45° field of view
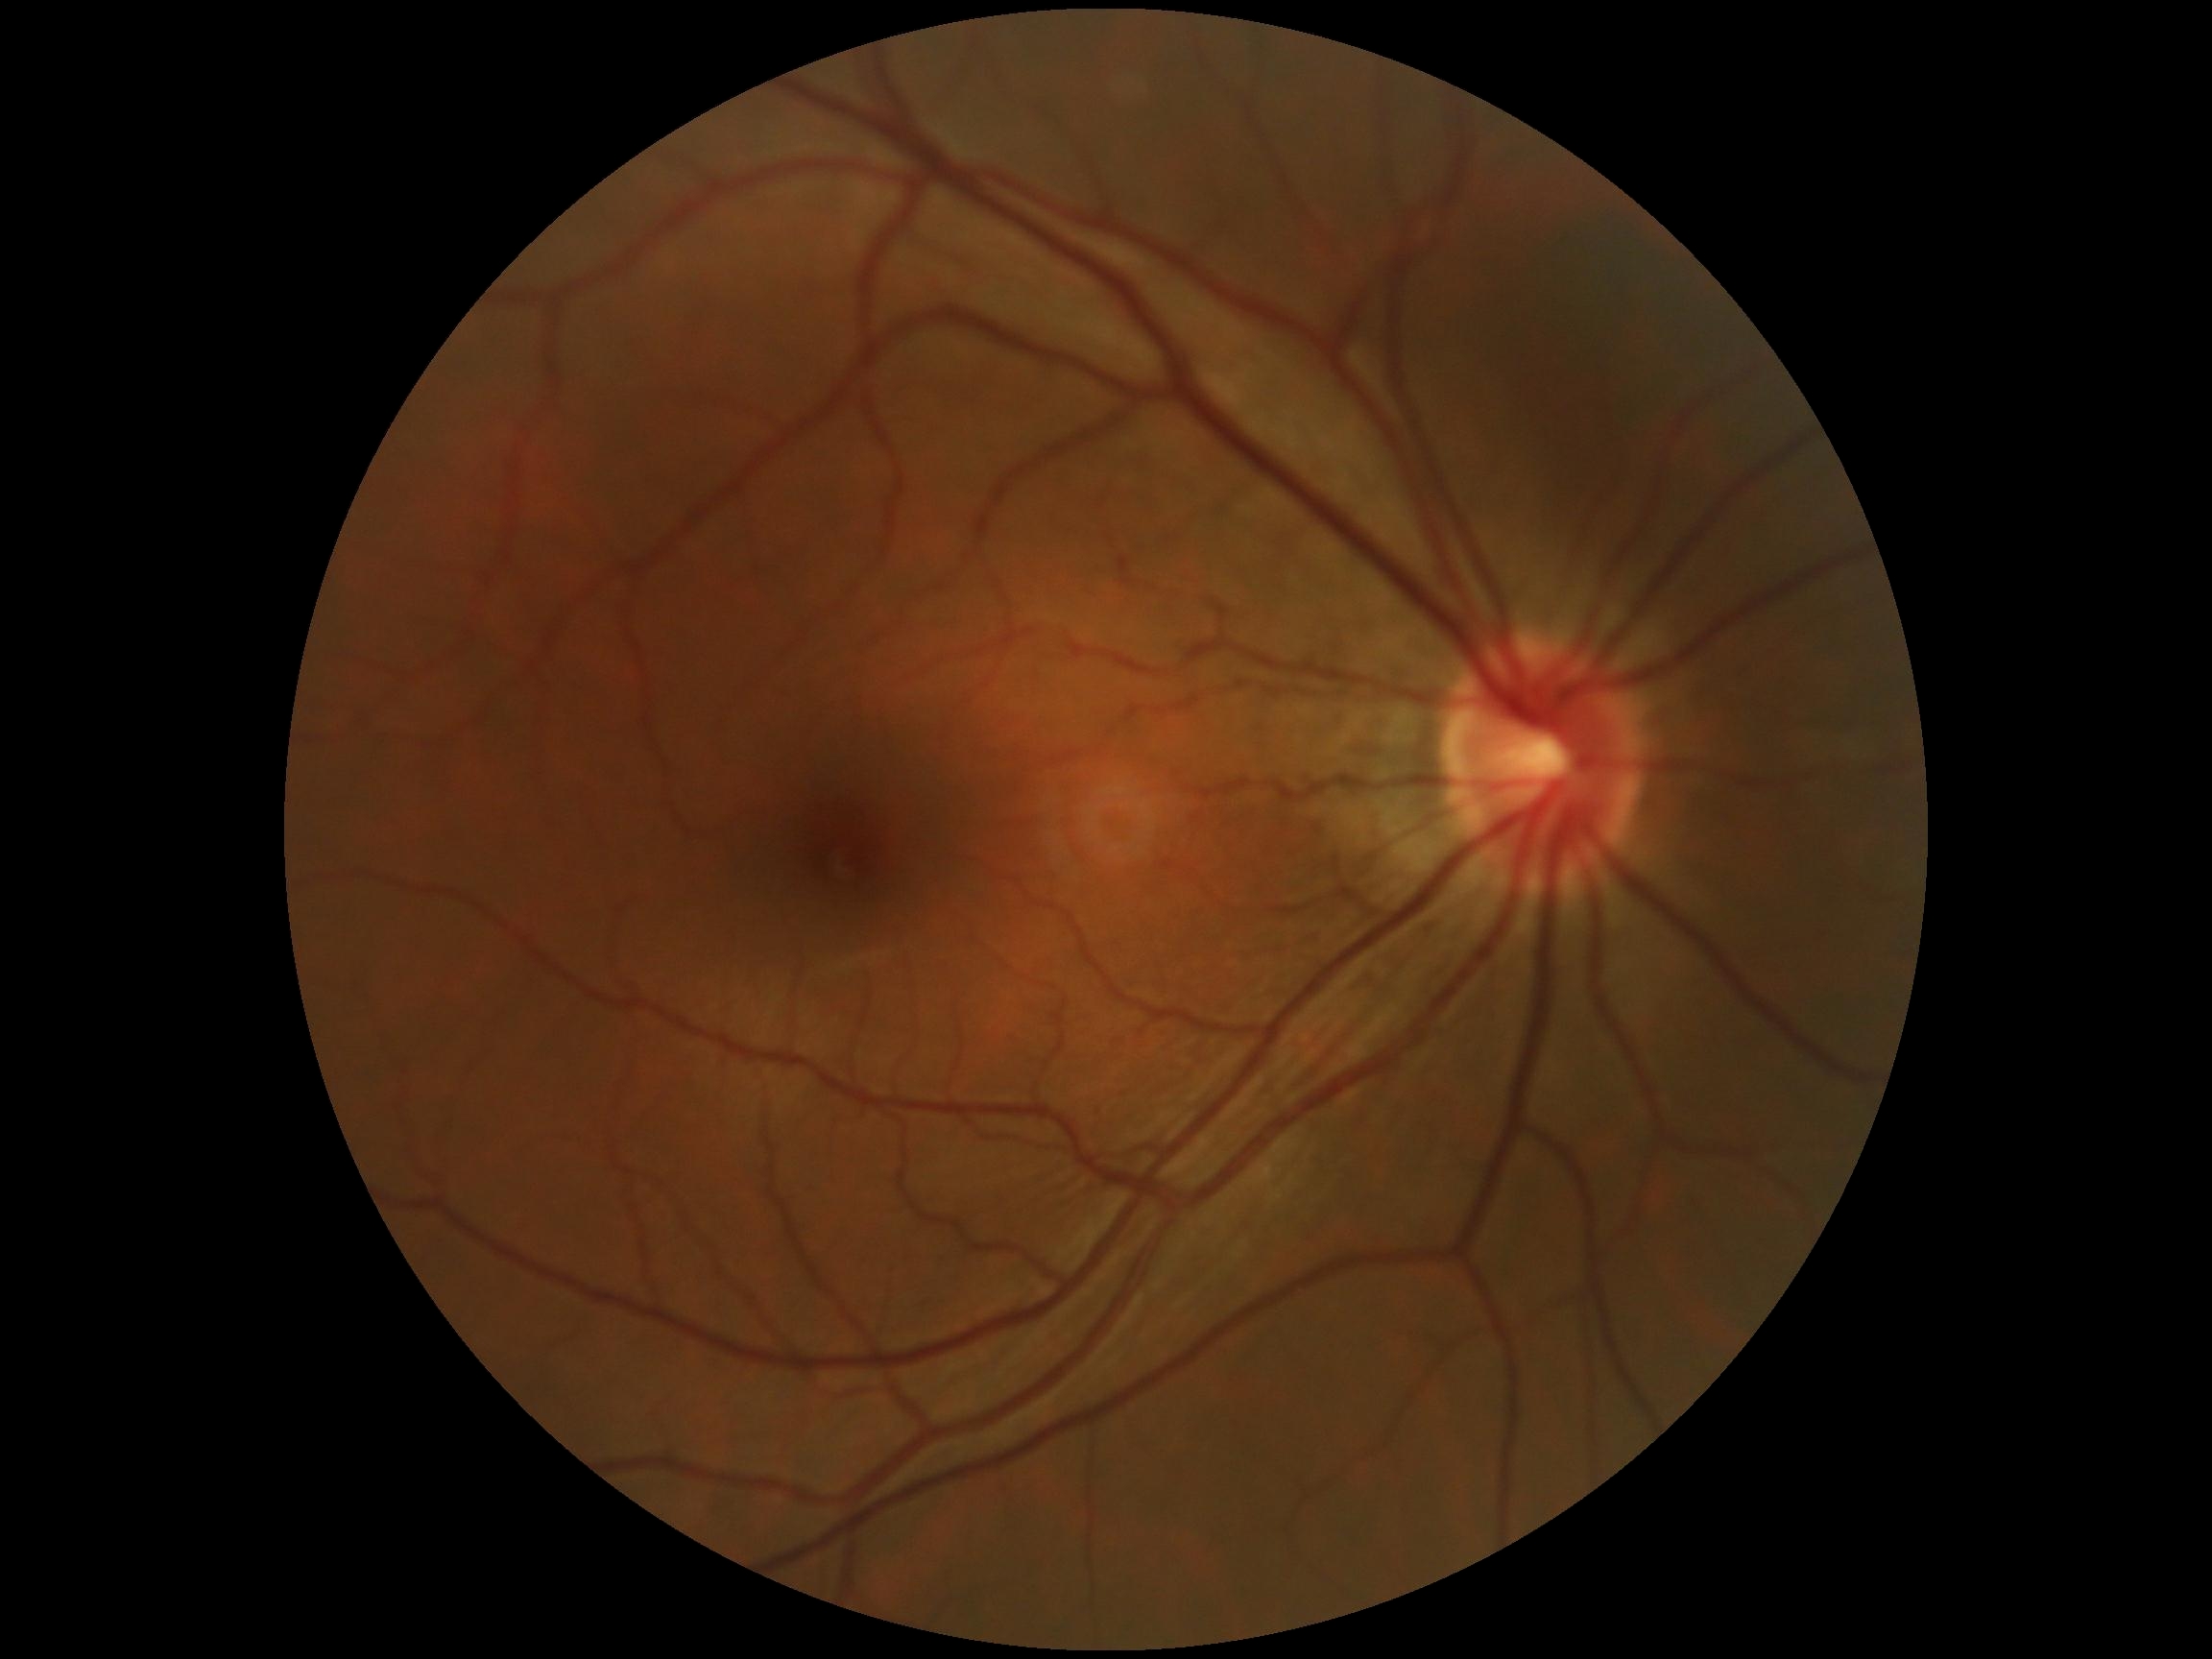 DR impression: no apparent DR; DR stage: grade 0.